No pharmacologic dilation. 848 by 848 pixels — 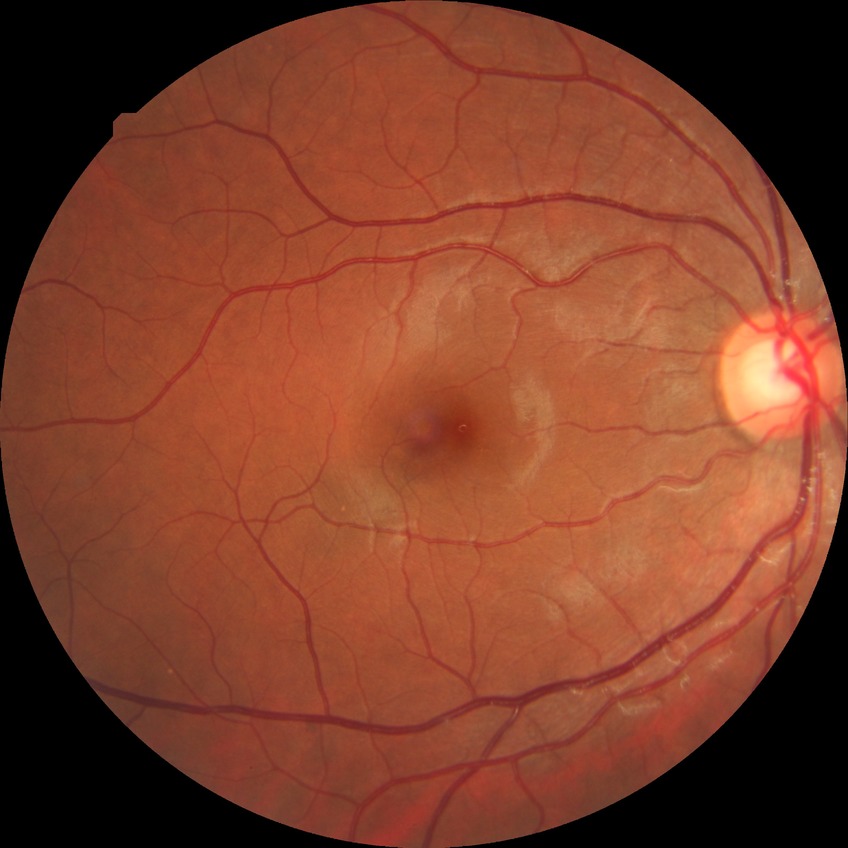 Modified Davis grading: no diabetic retinopathy.